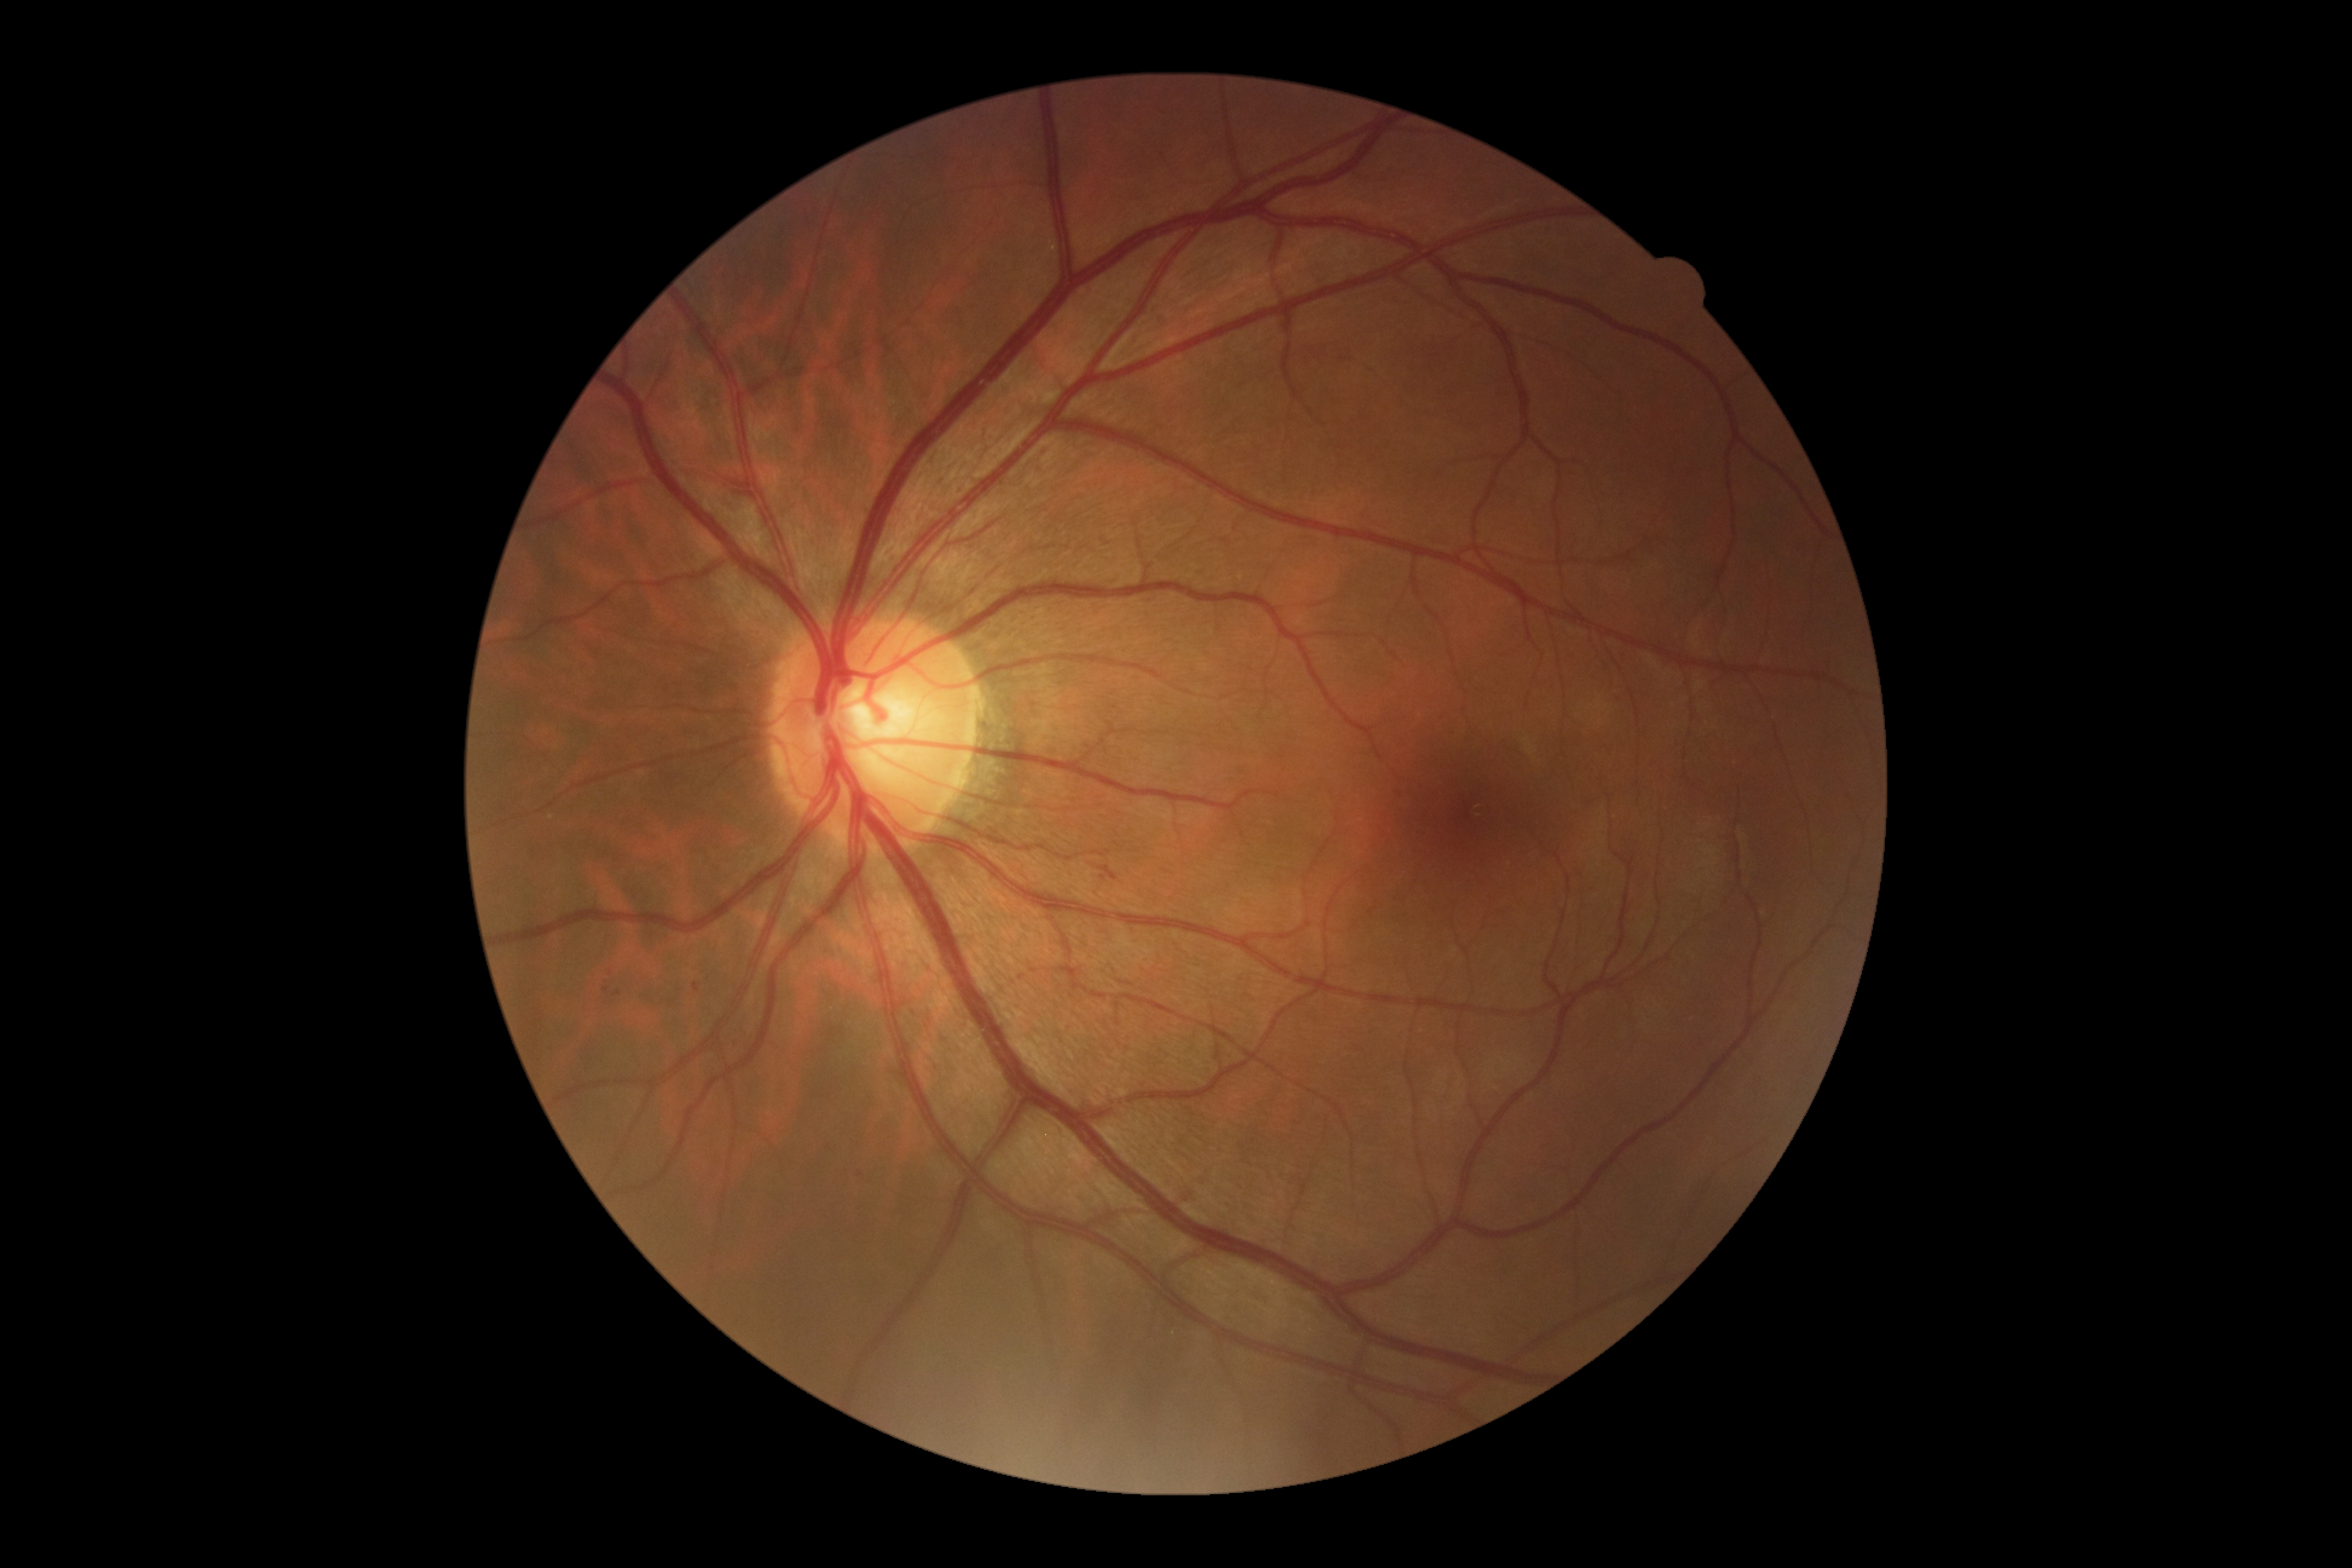 Diabetic retinopathy (DR): grade 2 (moderate NPDR).